FOV: 45 degrees. 2352x1568: 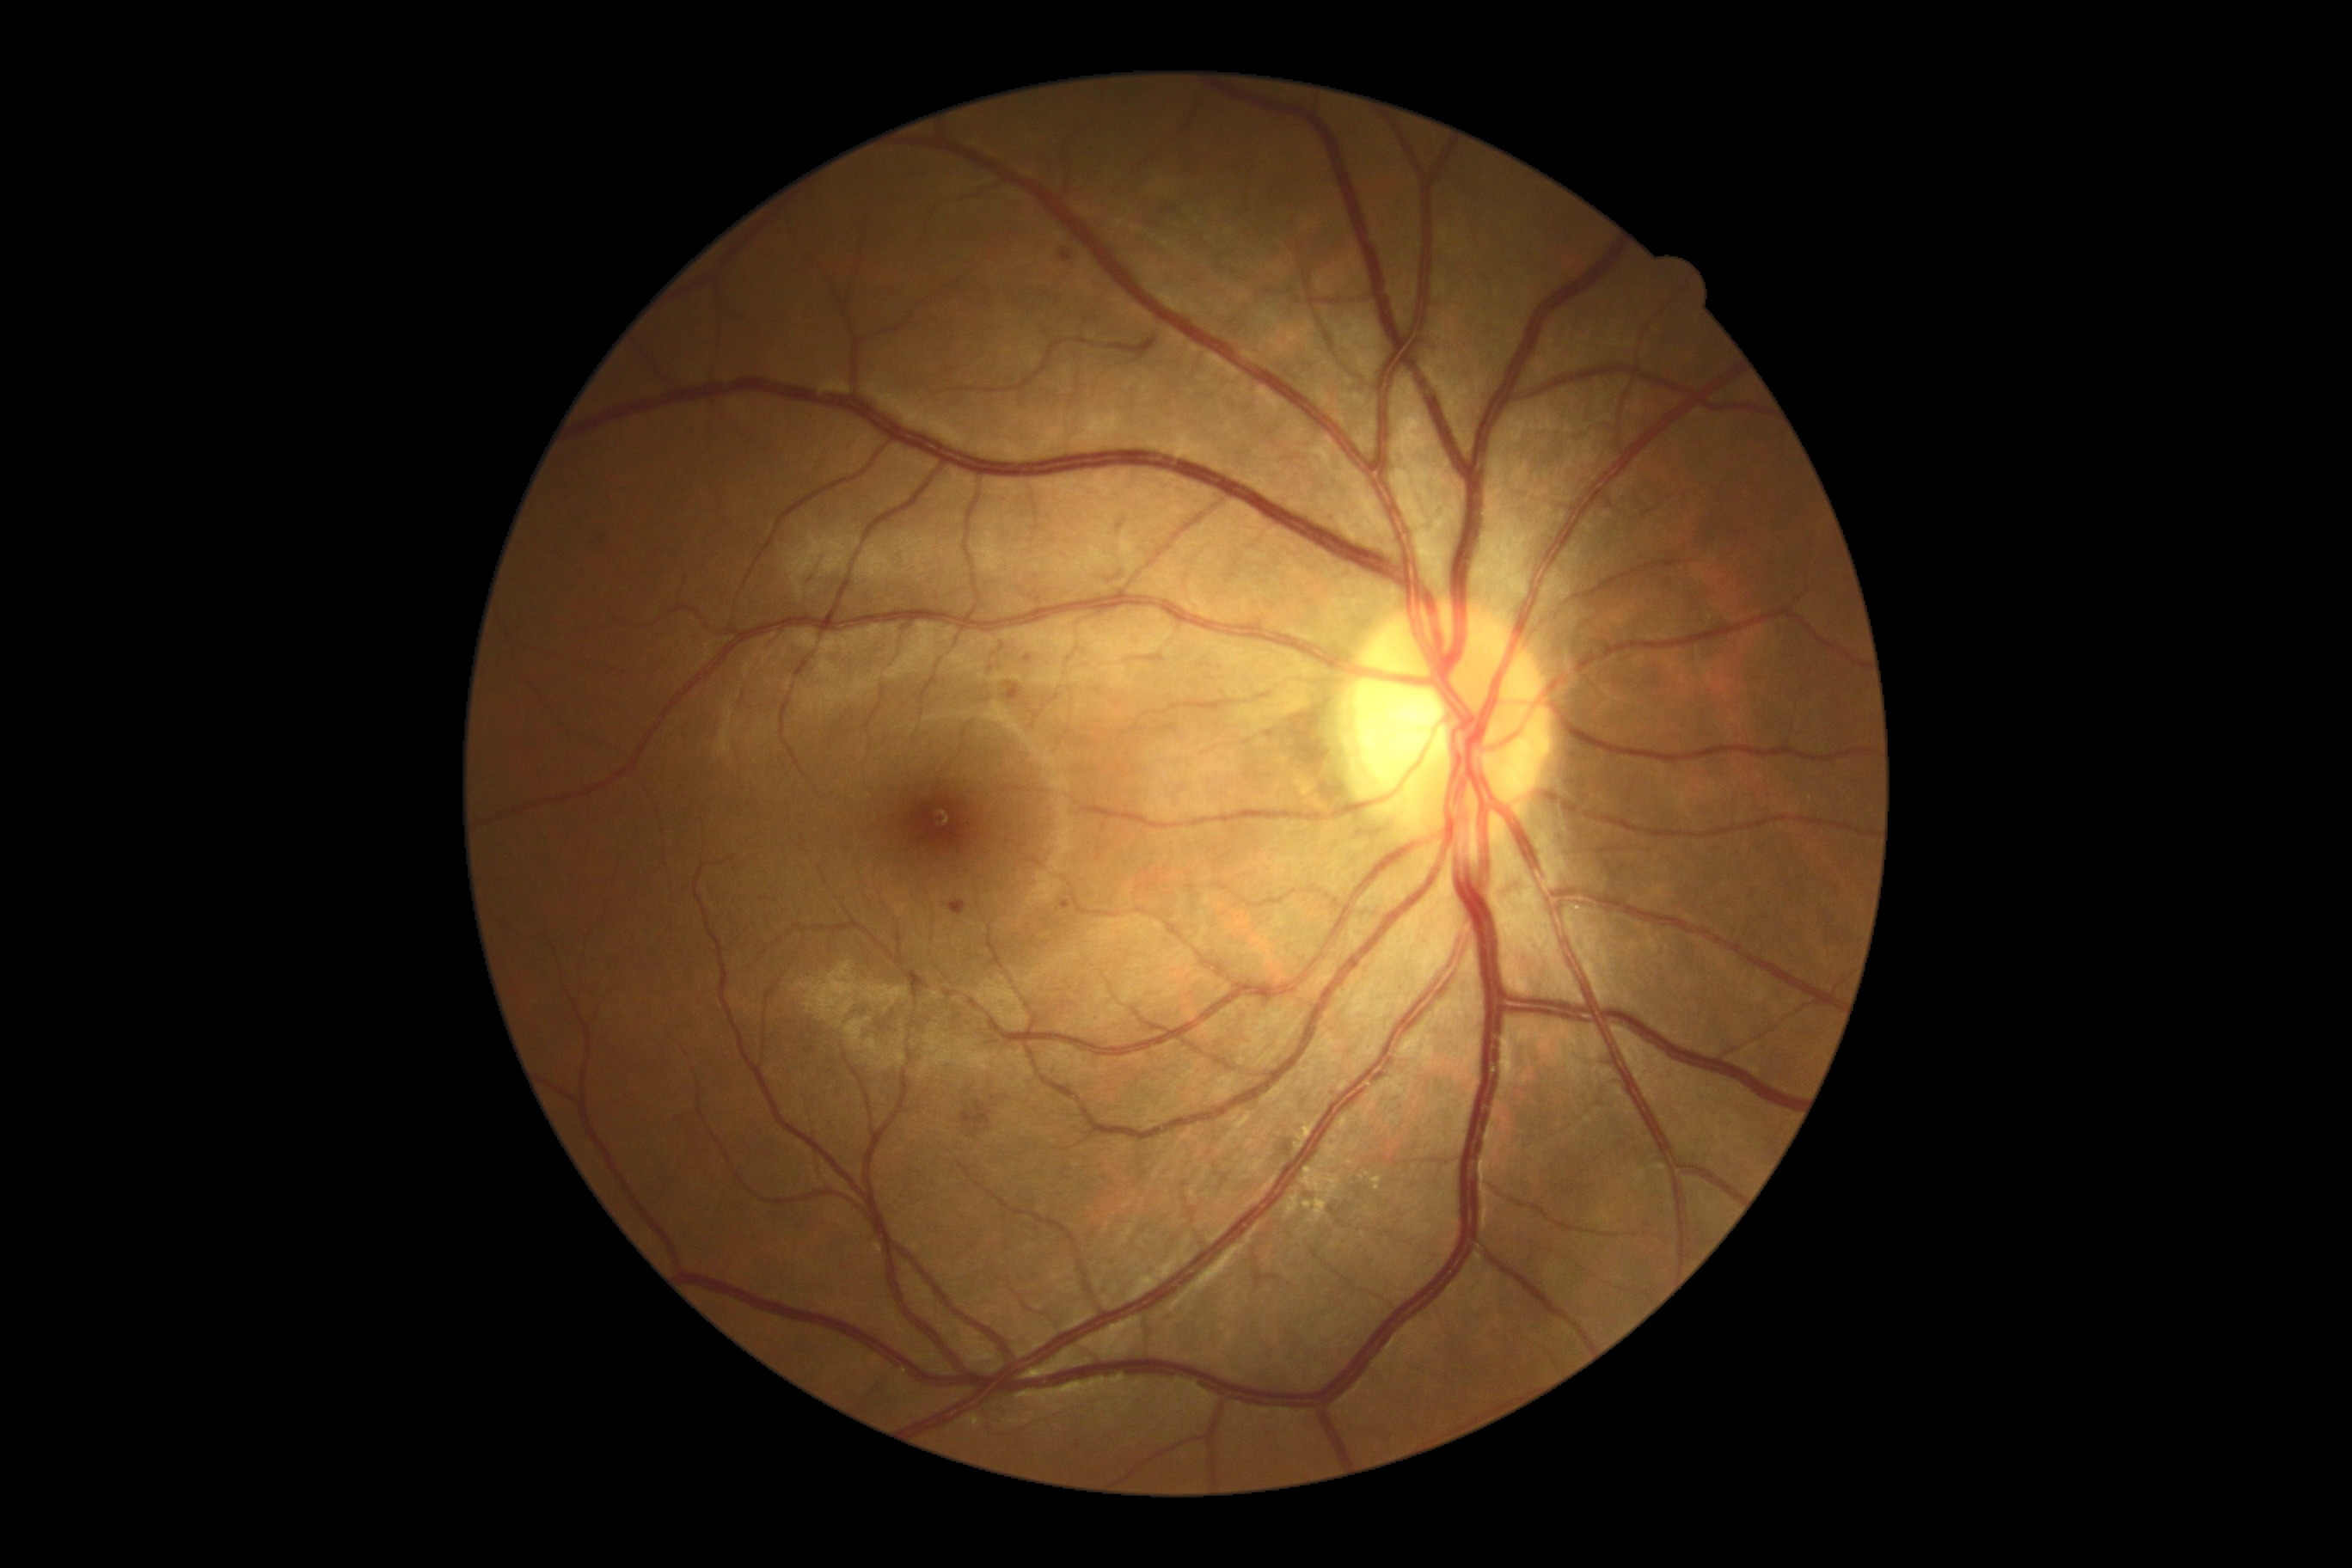
Retinopathy: moderate non-proliferative diabetic retinopathy (grade 2).